45-degree field of view, color fundus photograph:
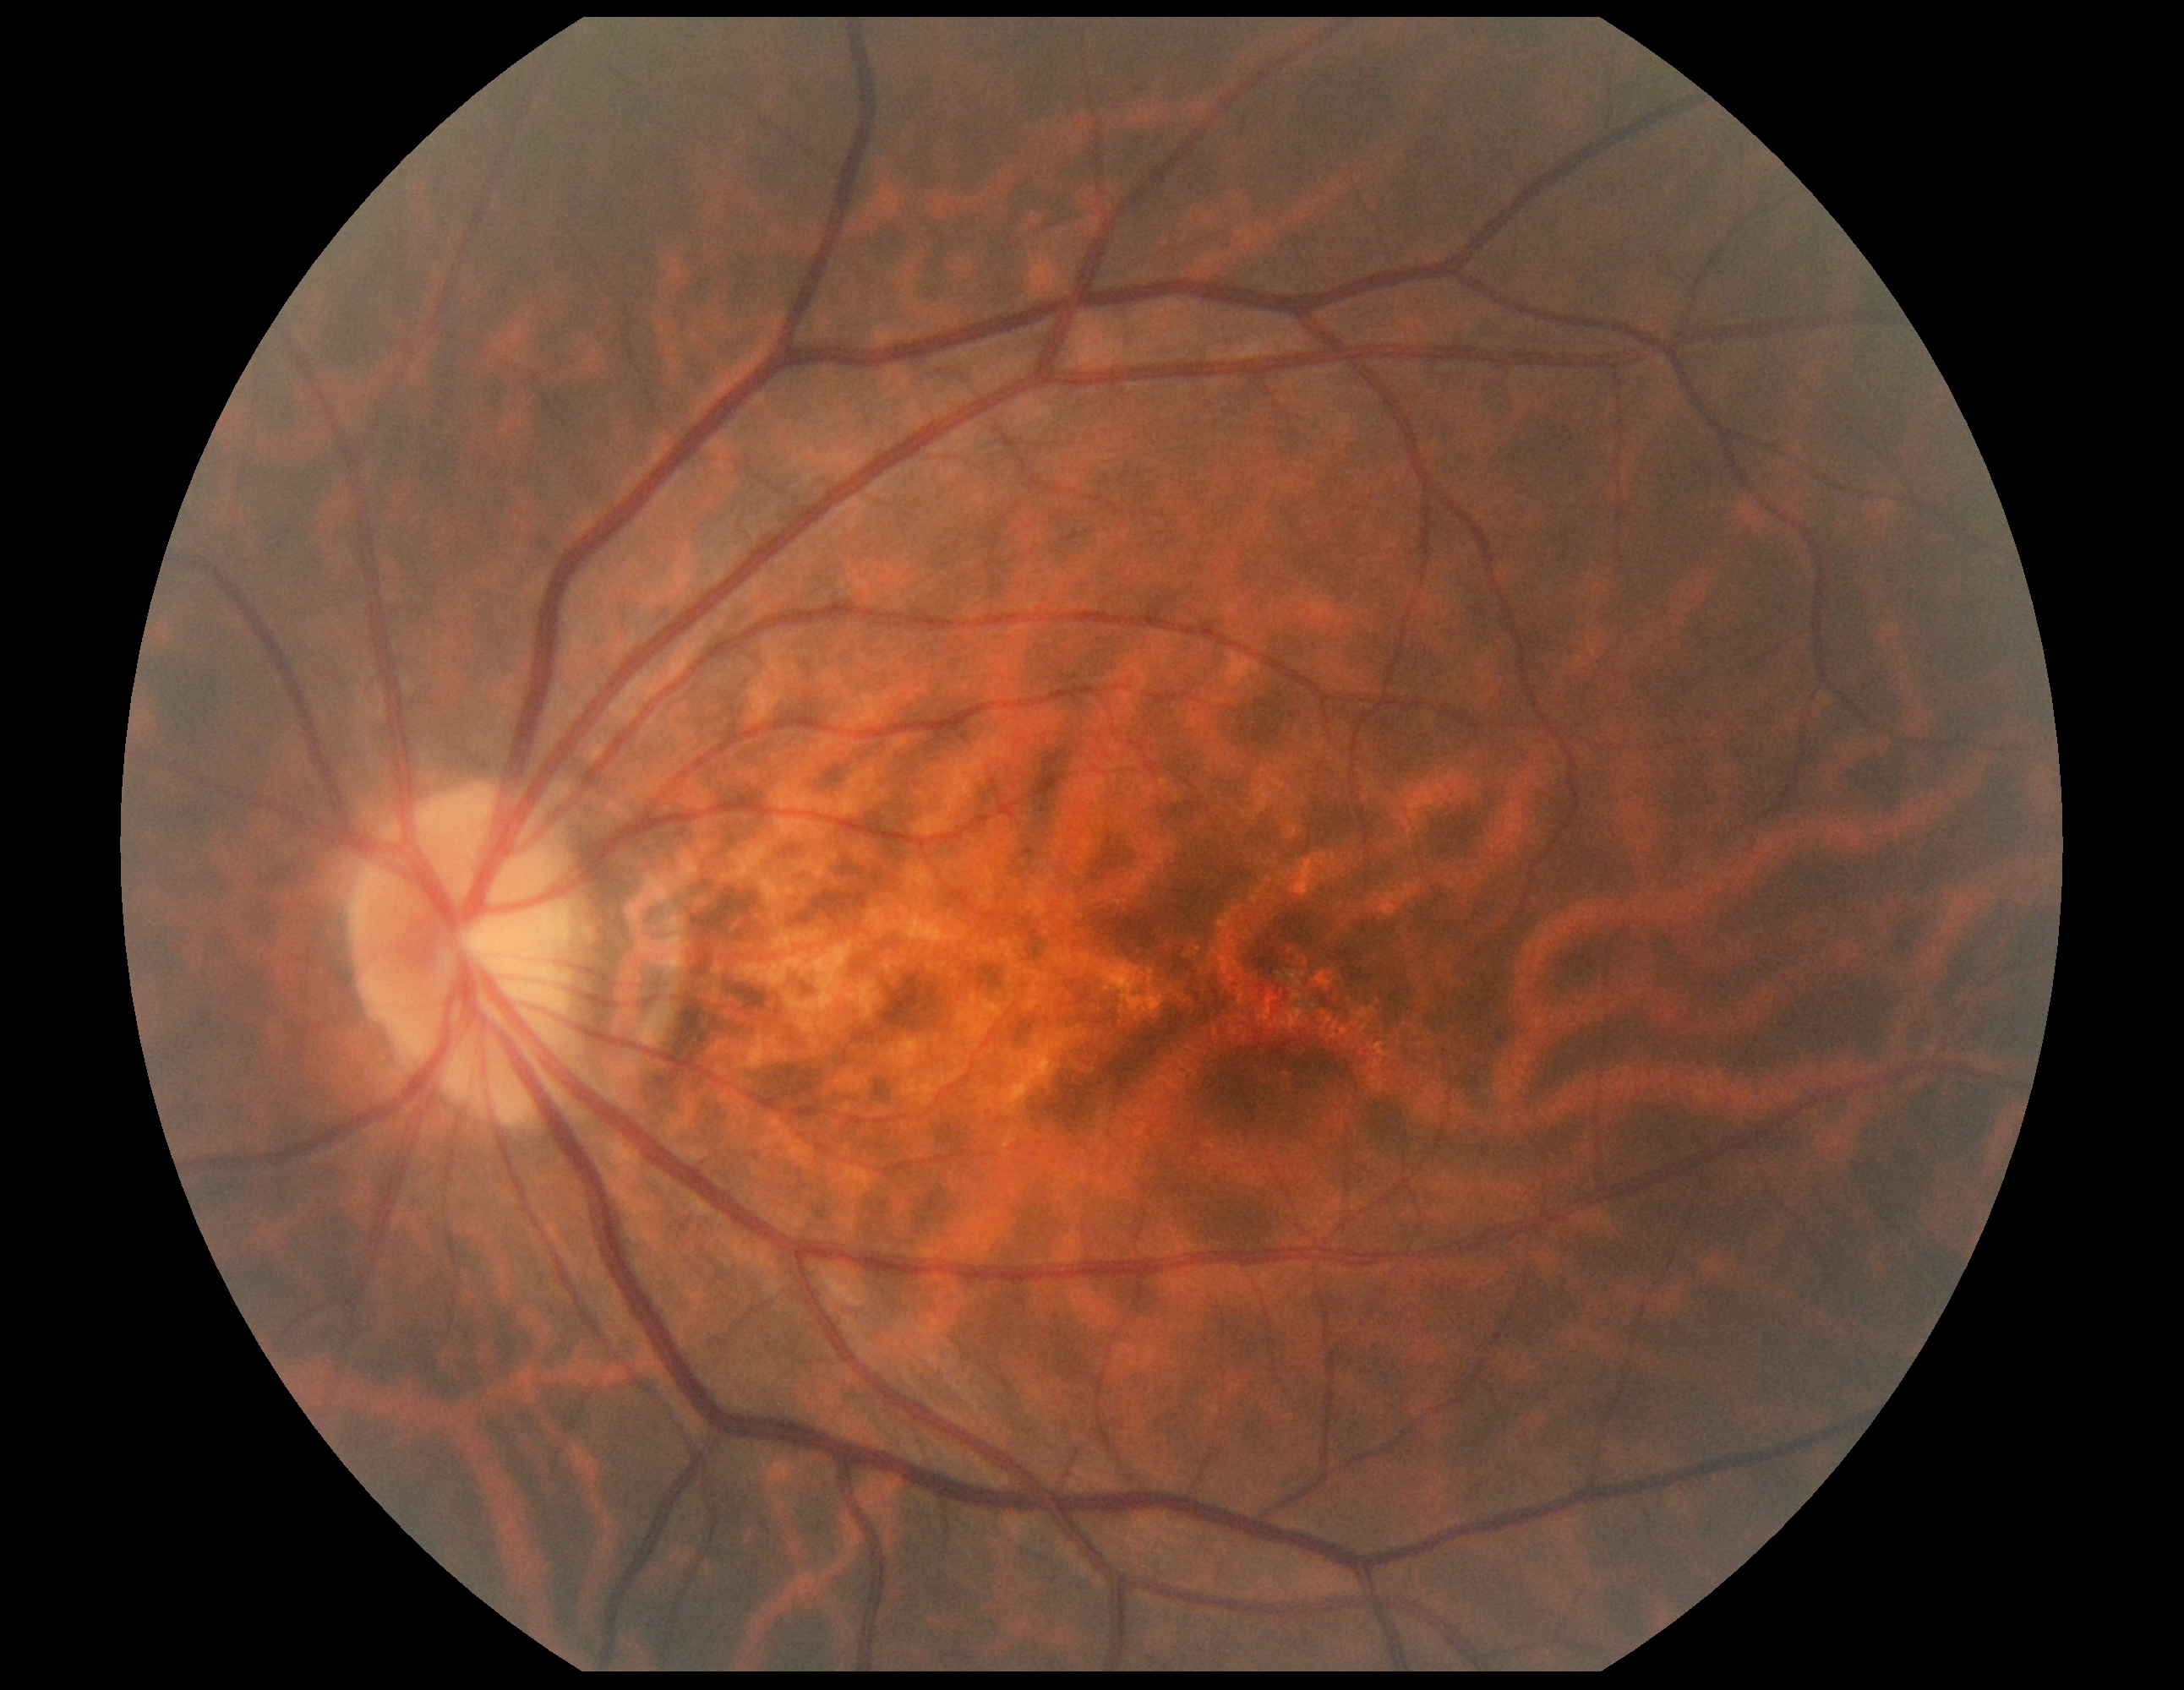

- DR severity: no apparent retinopathy (grade 0)